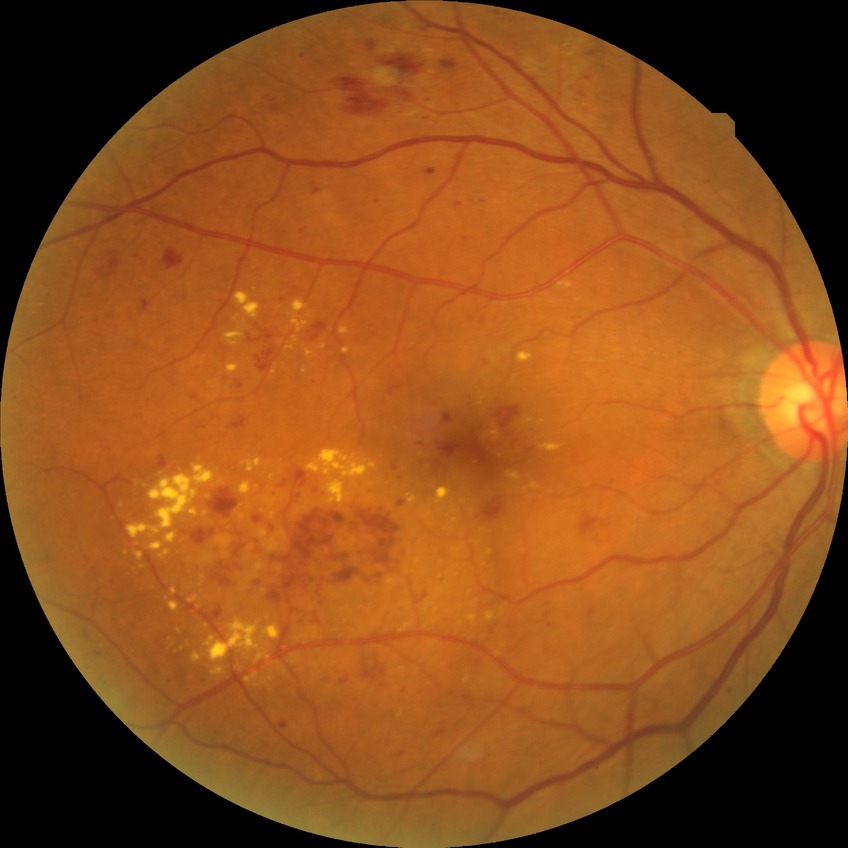
  davis_grade: pre-proliferative diabetic retinopathy (PPDR)